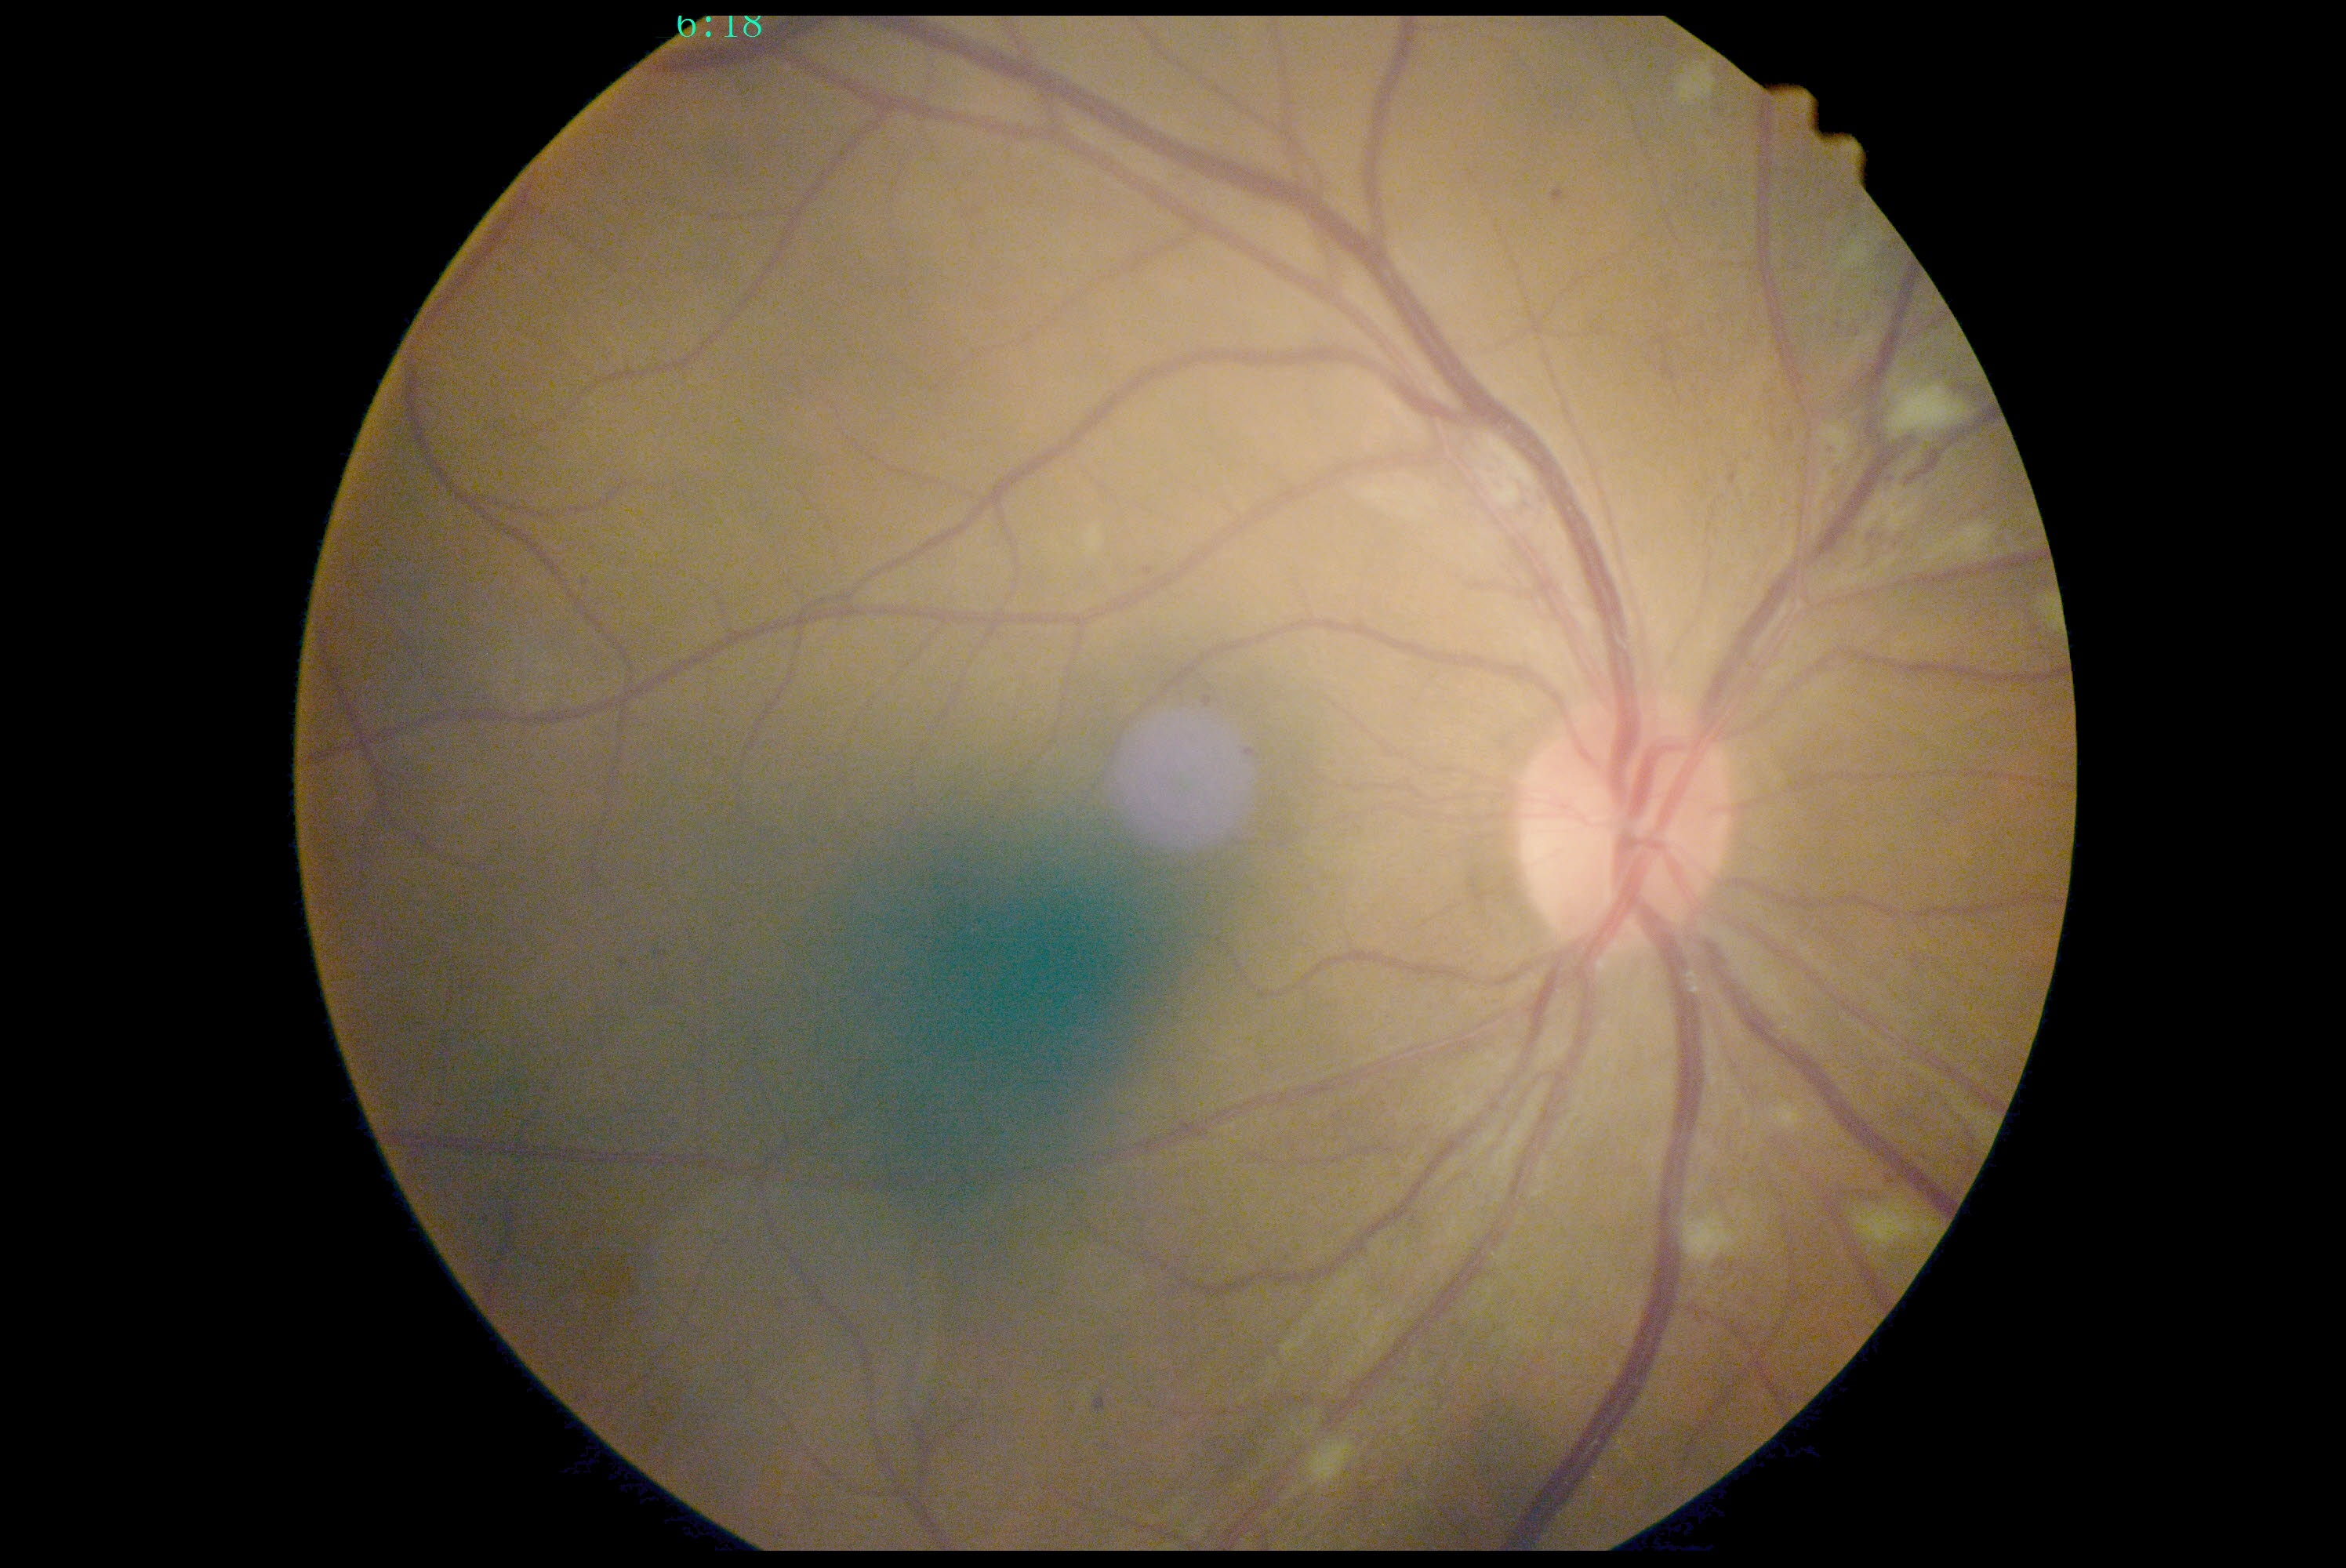 DR grade is 2 (moderate NPDR).